Image size 1960x1897; 45° FOV; CFP:
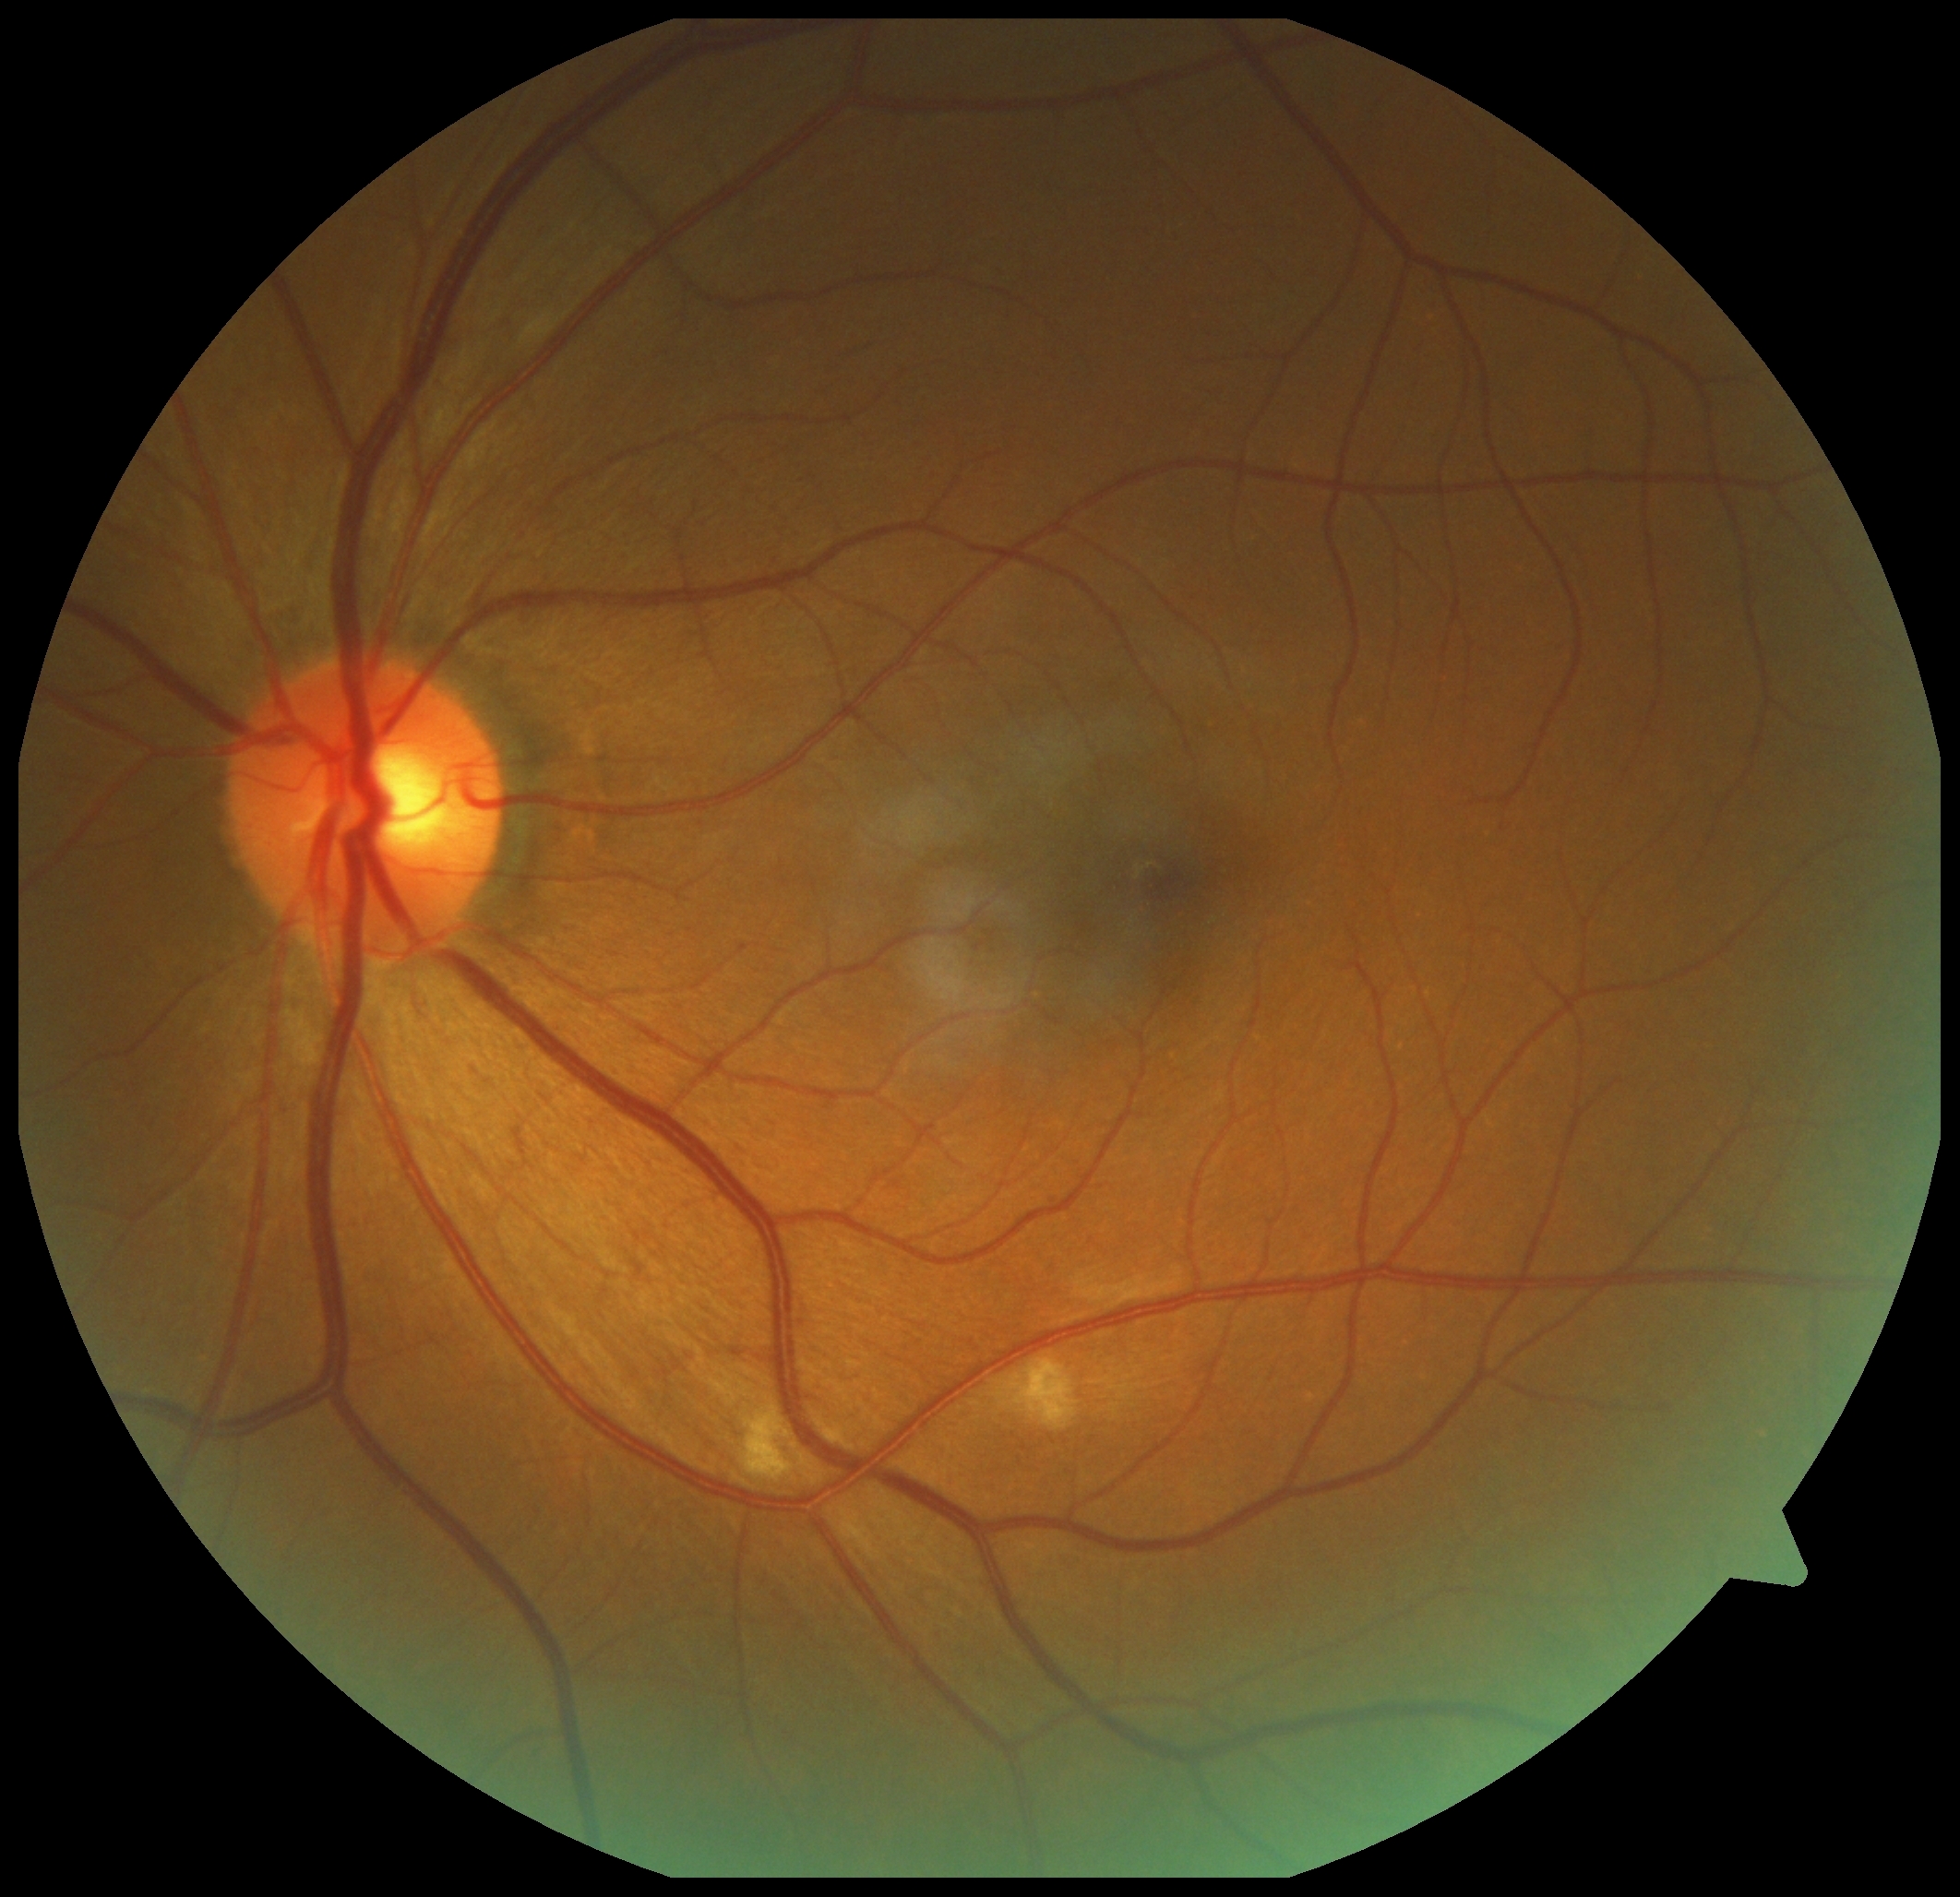
• diabetic retinopathy (DR): 2